2352x1568px. 45° FOV
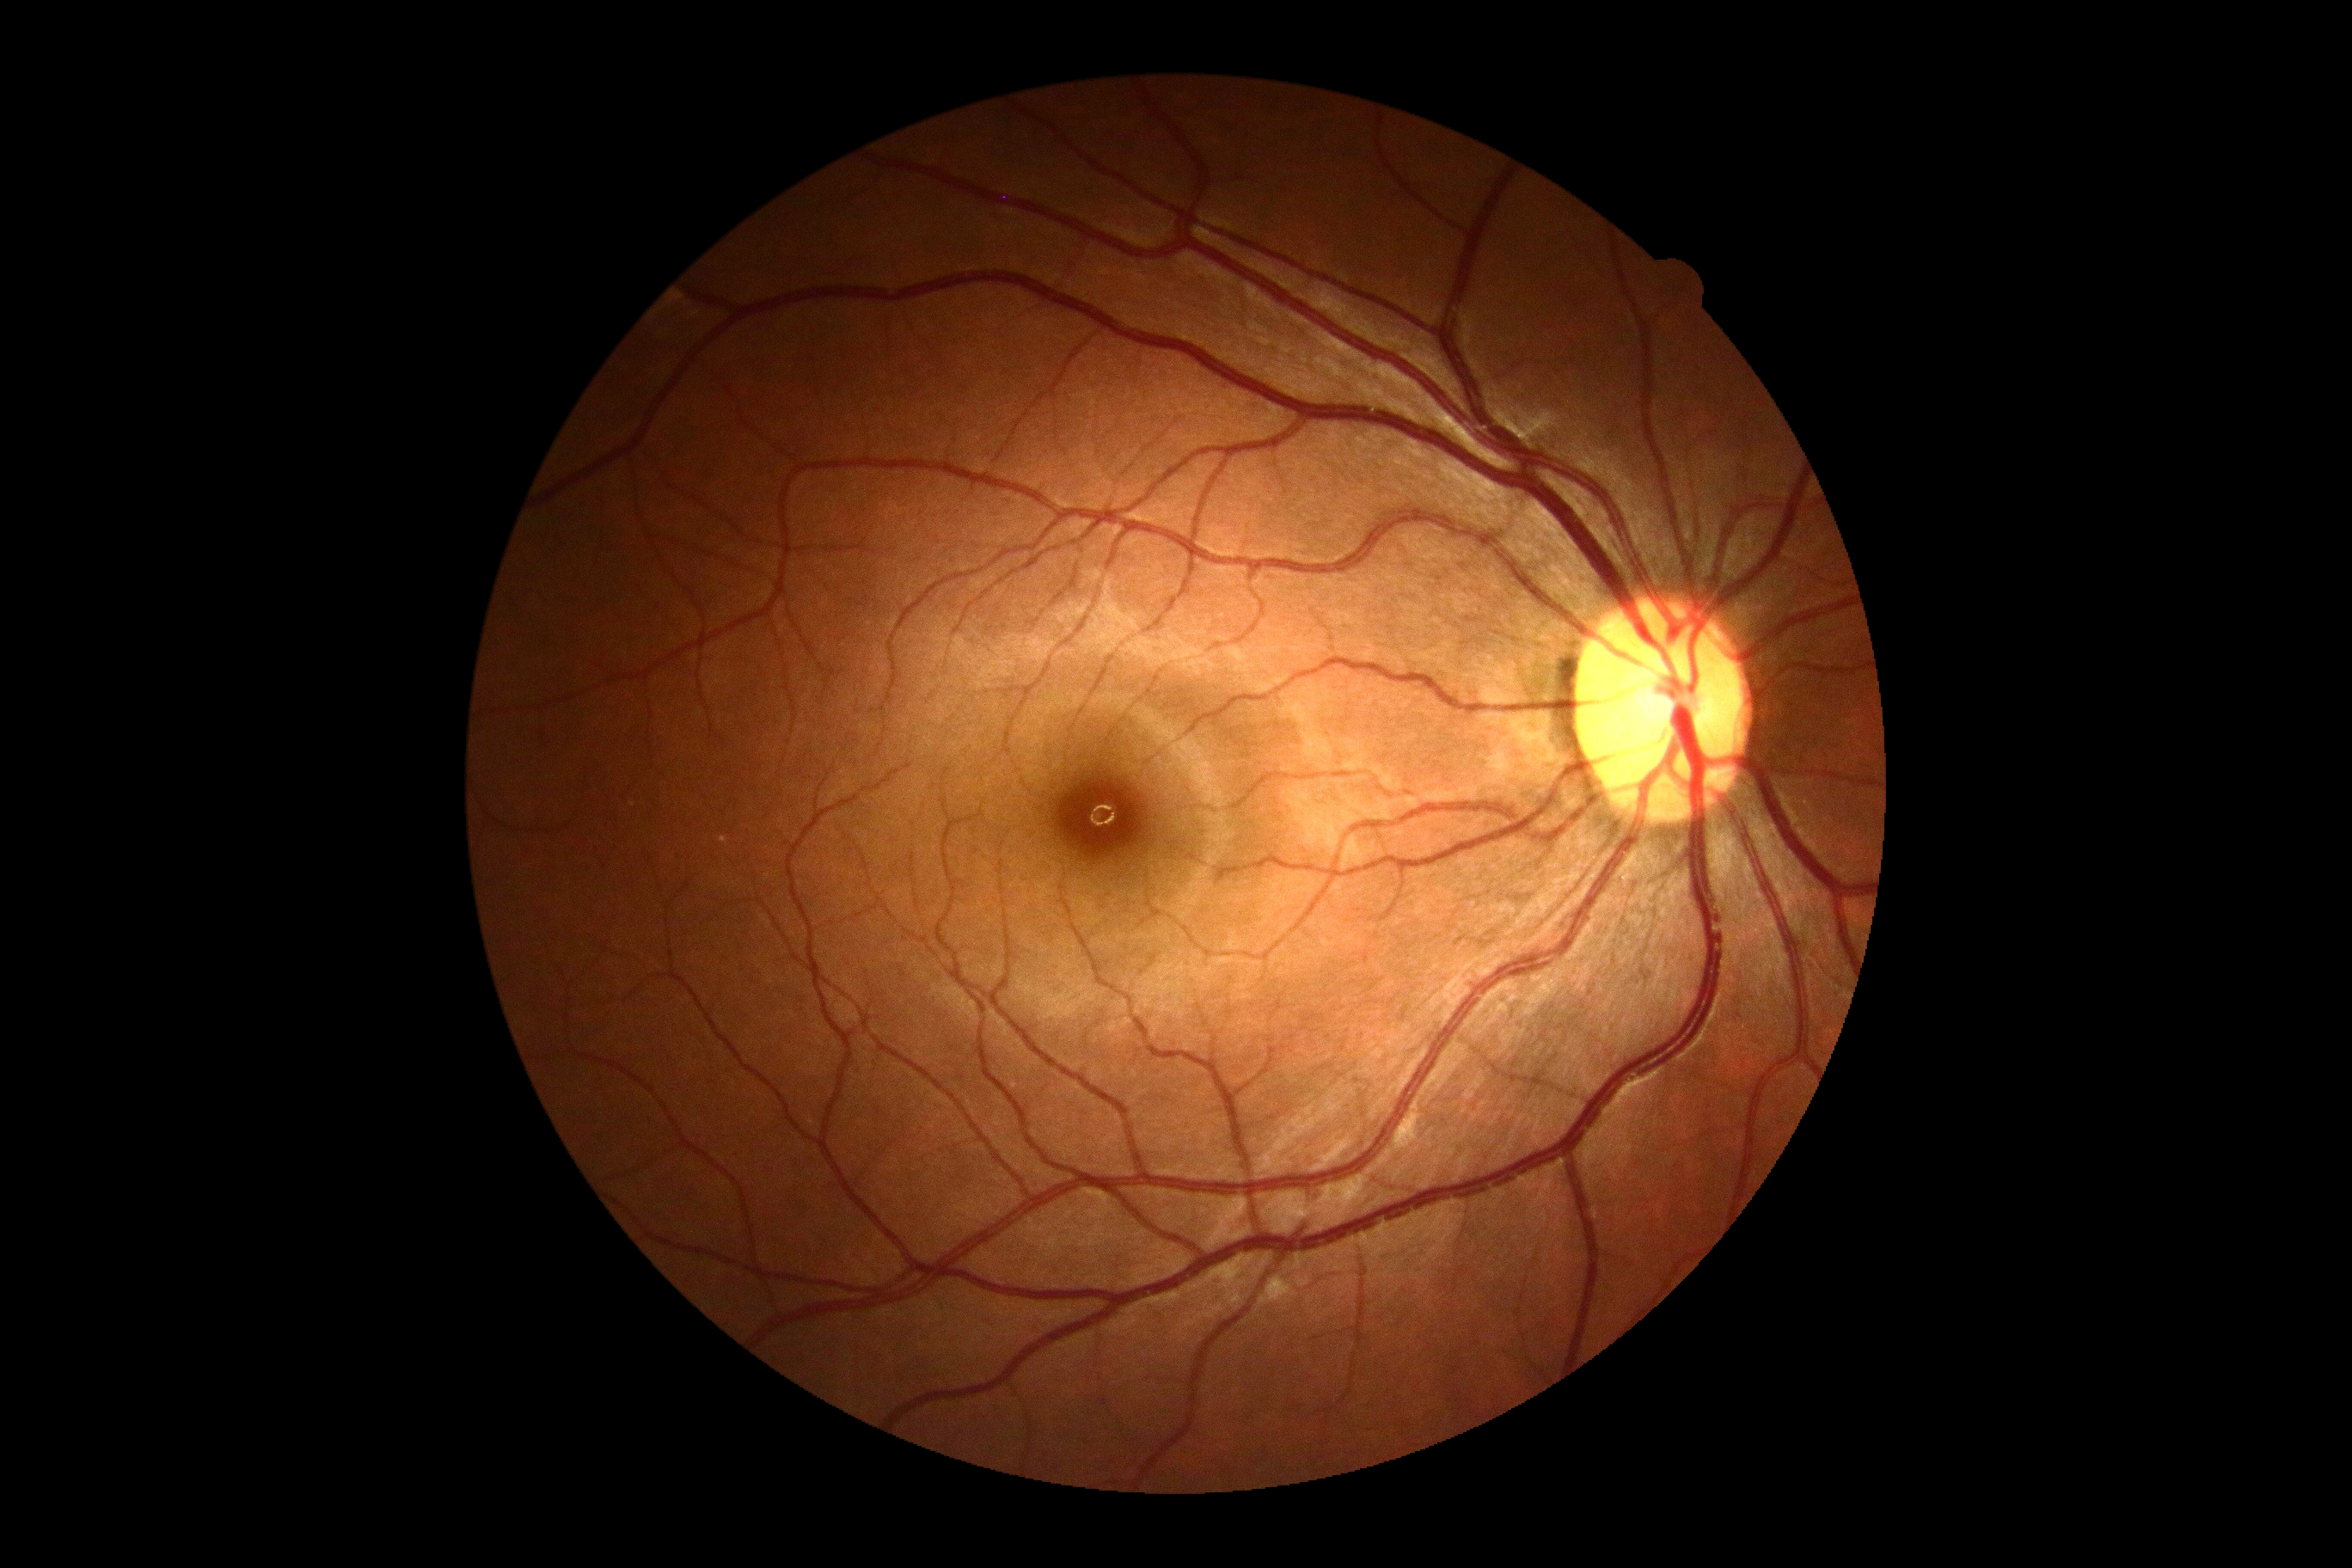
DR is grade 0 (no apparent retinopathy) — no visible signs of diabetic retinopathy.